Pediatric retinal photograph (wide-field): 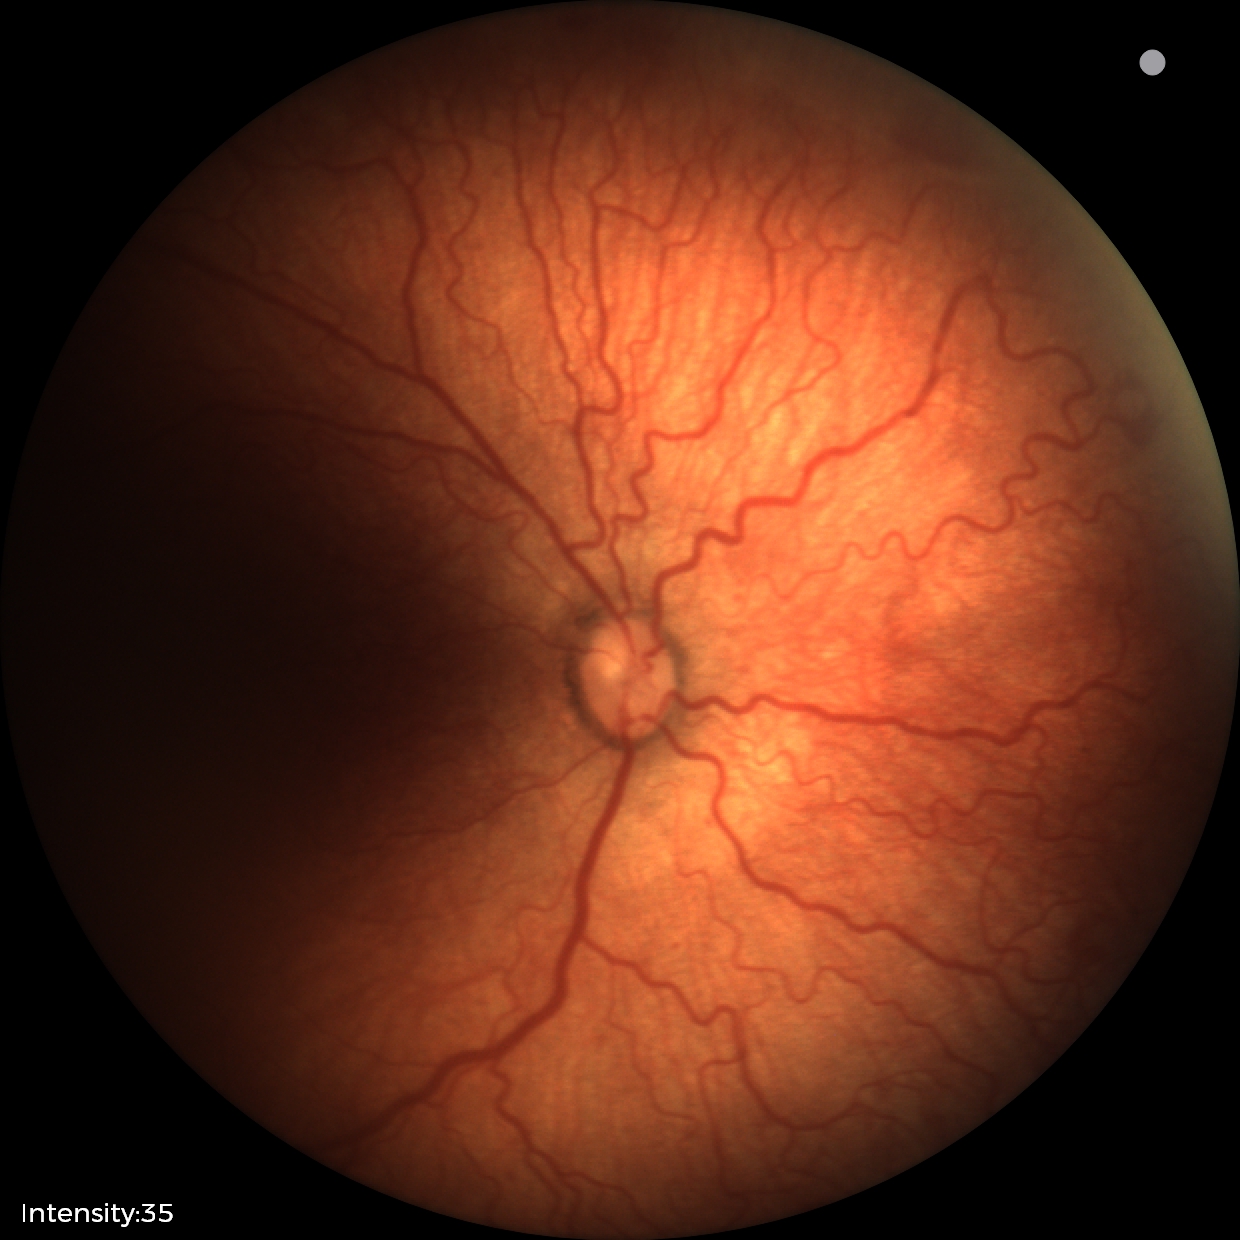 Plus disease was diagnosed. From an examination with diagnosis of retinopathy of prematurity stage 2.